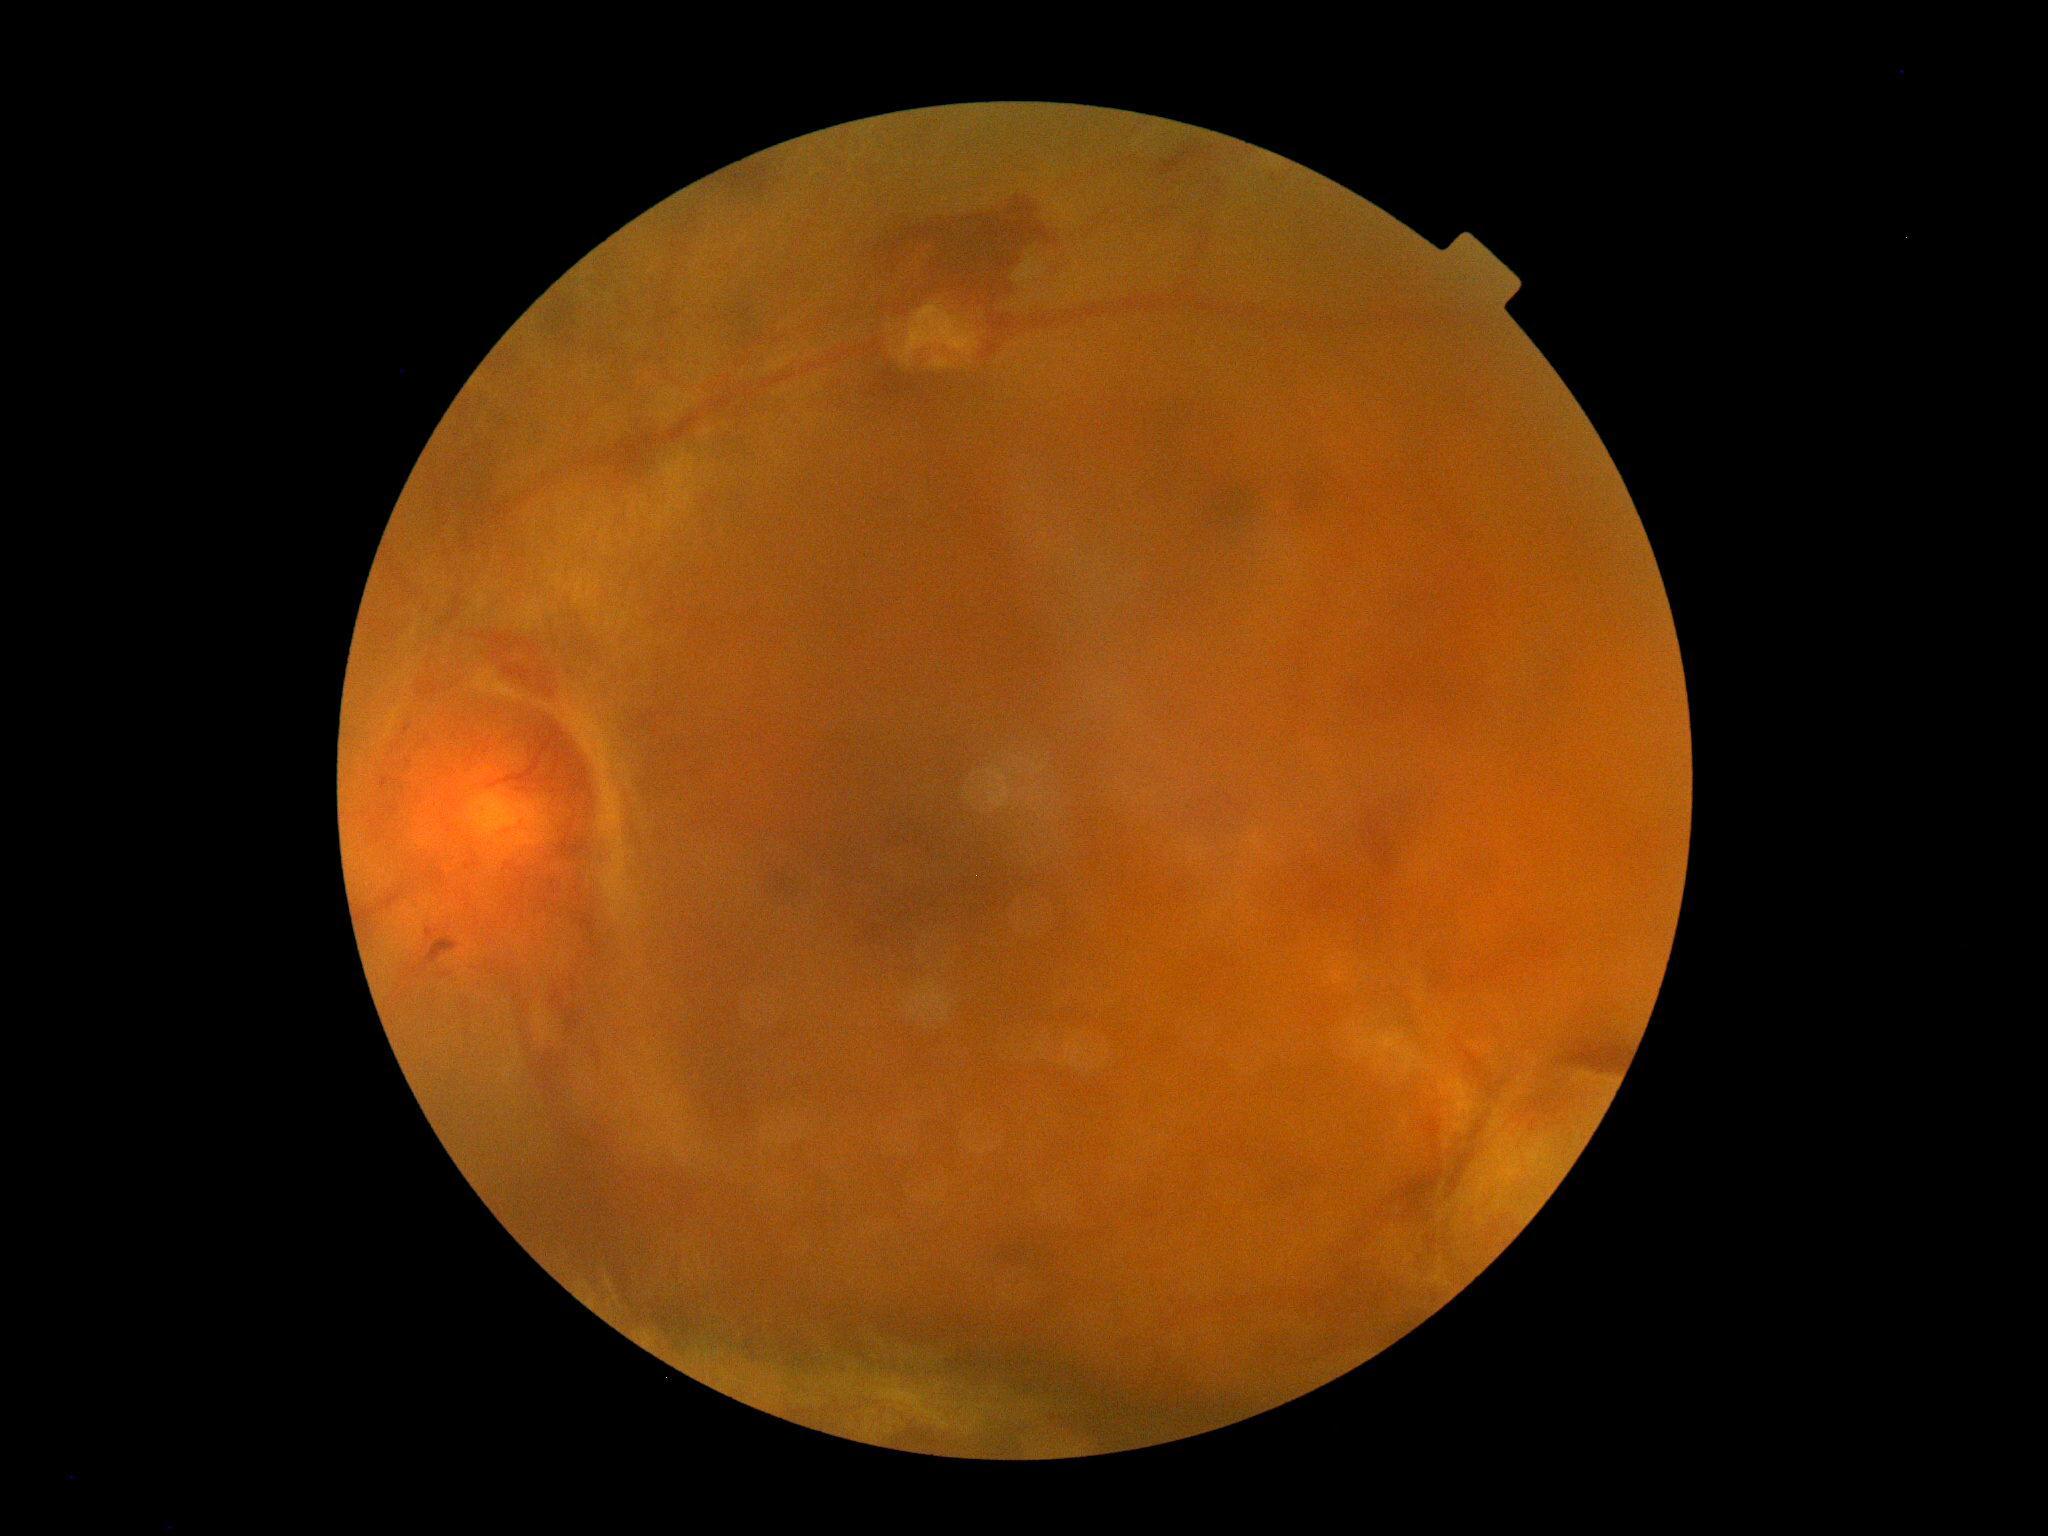
DR=grade 4 (PDR) — neovascularization and/or vitreous/pre-retinal hemorrhage; DR class=proliferative diabetic retinopathy.